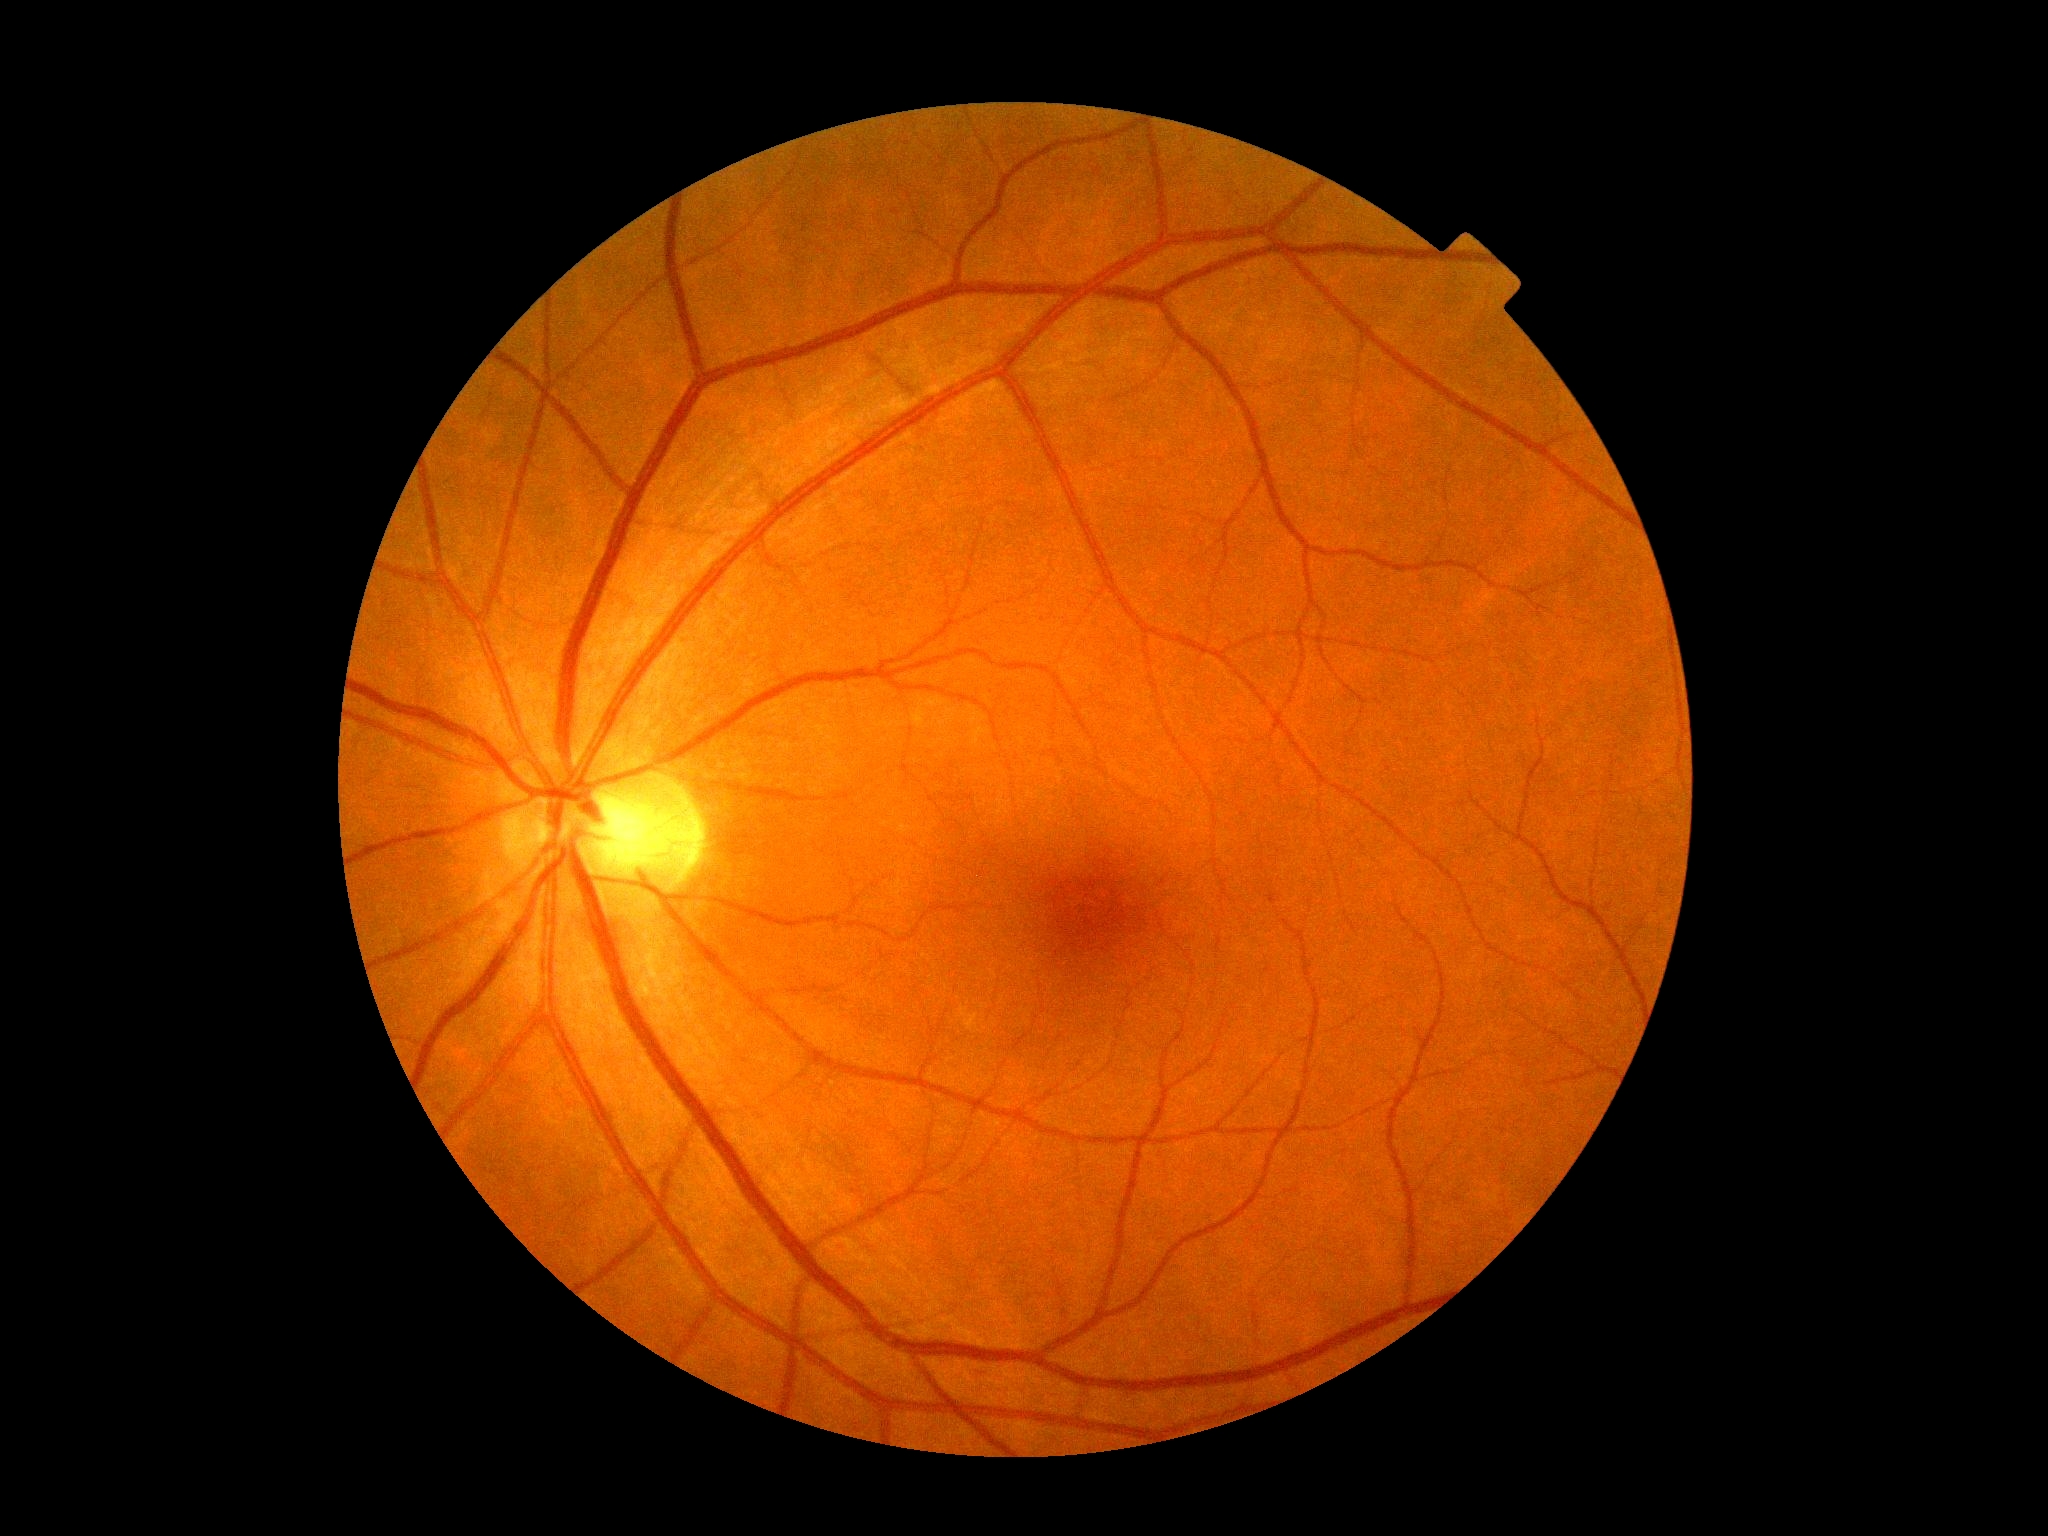

Diabetic retinopathy is grade 0 (no apparent retinopathy) — no visible signs of diabetic retinopathy.